Wide-field fundus image from infant ROP screening. 1240x1240. Acquired on the Phoenix ICON
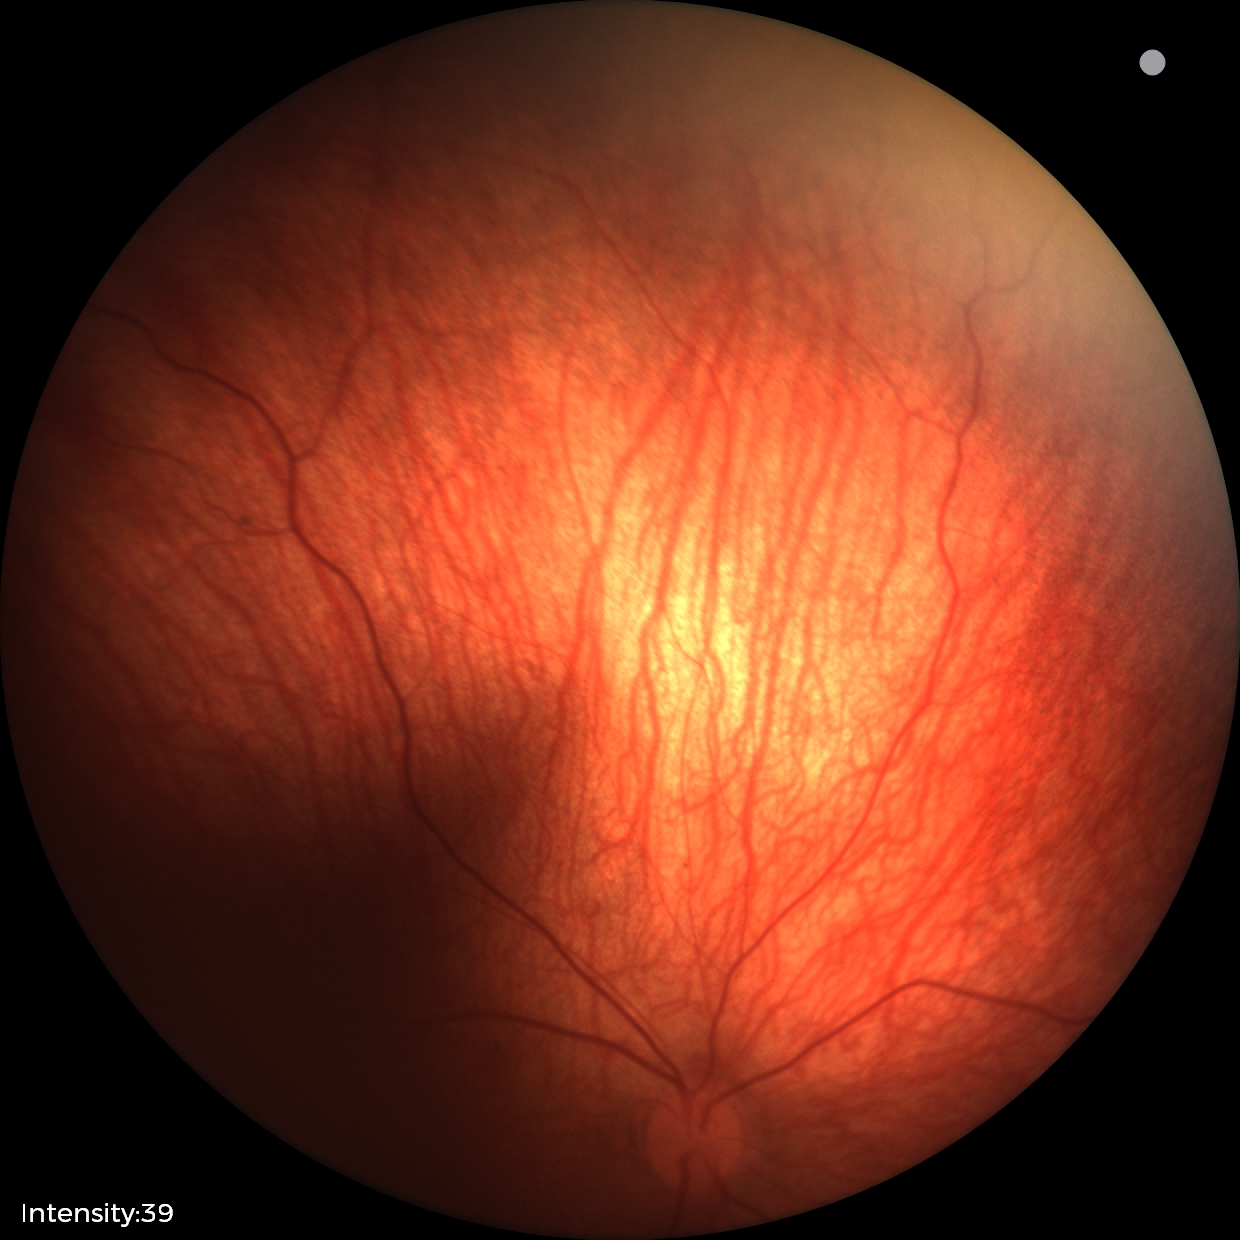 Examination diagnosed as retinal hemorrhages.